45° field of view, nonmydriatic: 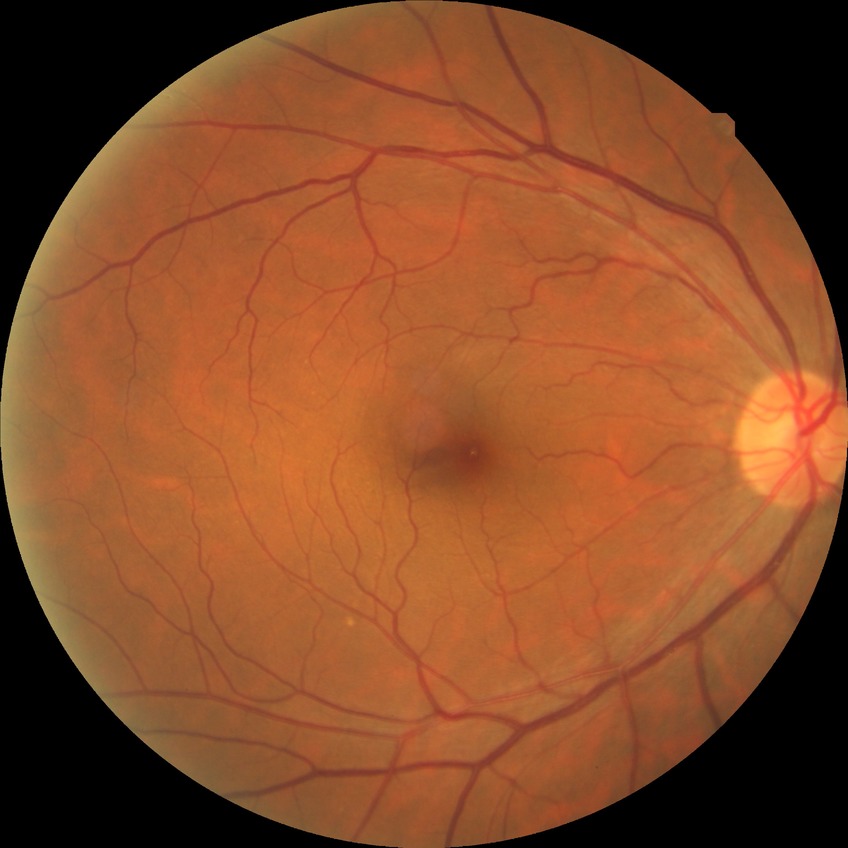
Diabetic retinopathy grade is no diabetic retinopathy.